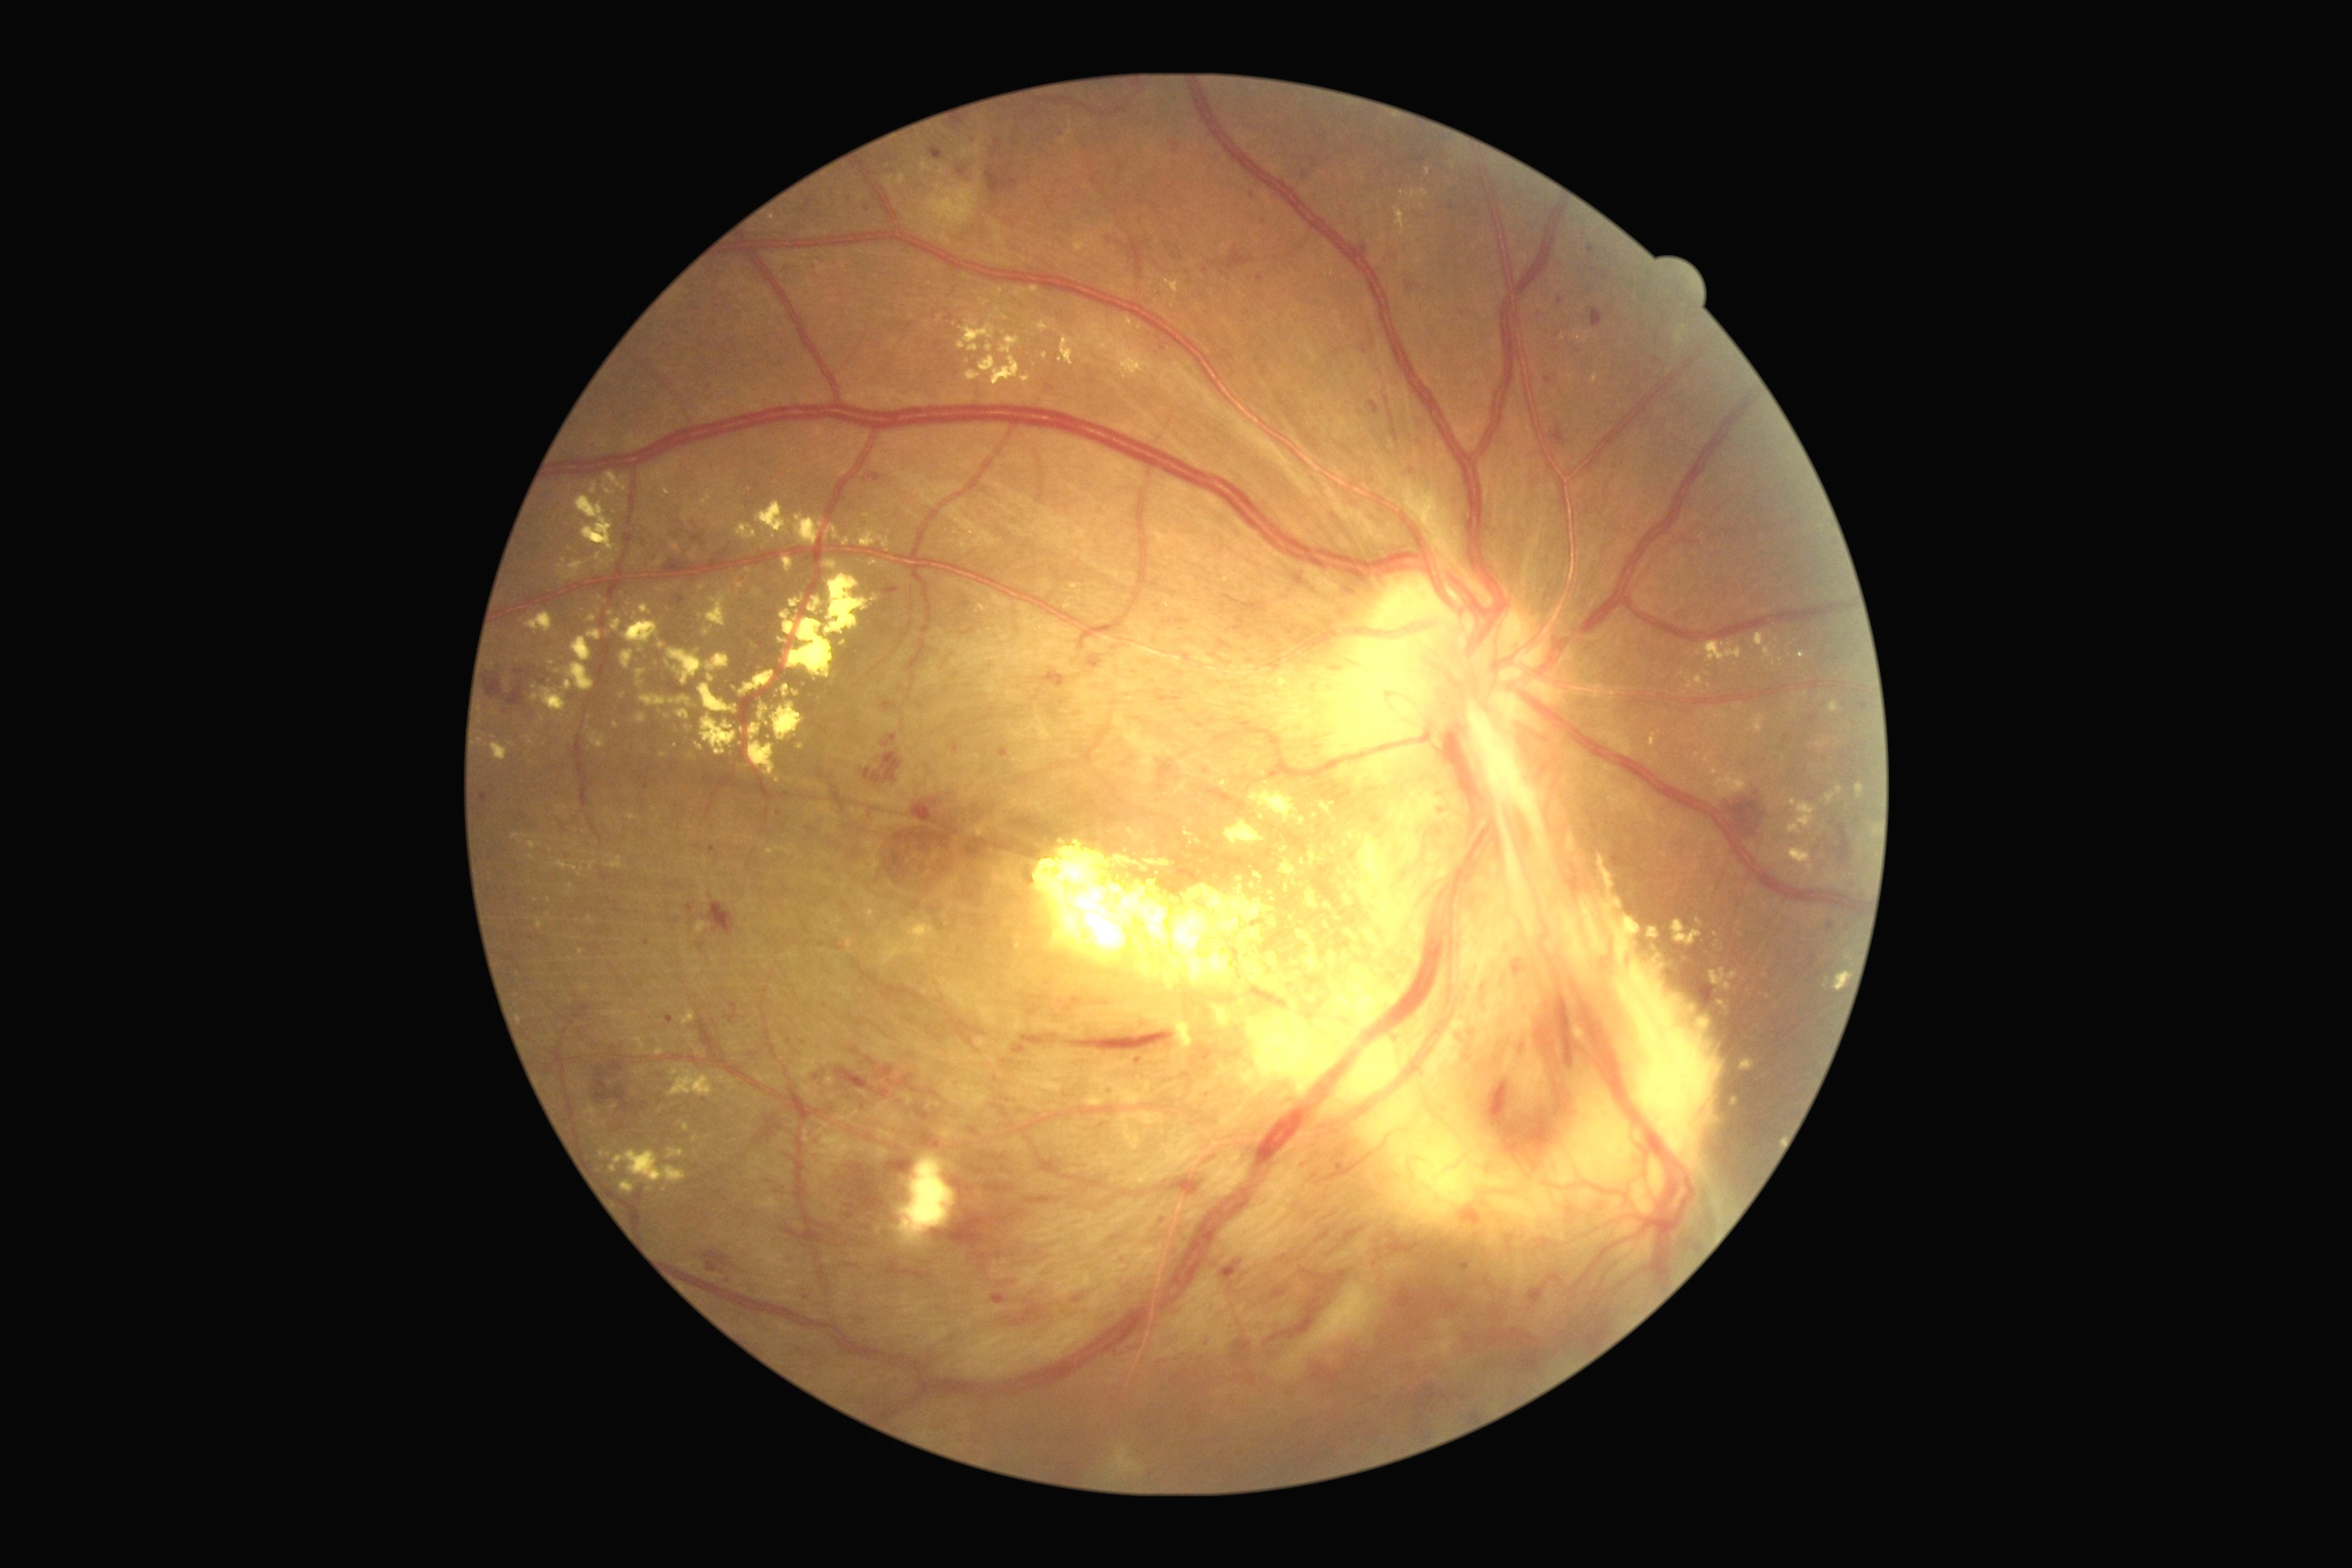 DR grade is 4 (PDR); proliferative diabetic retinopathy
Lesions identified (partial list):
EXs (subset) = 696,923,709,934 | 554,669,562,674 | 736,583,745,591 | 654,1048,665,1057 | 1827,787,1843,805 | 752,589,761,598 | 1669,917,1705,946 | 669,1064,714,1097 | 525,612,553,632 | 747,642,760,654 | 1034,841,1275,974 | 736,525,758,542 | 683,1010,696,1026
Smaller EXs around [x=998, y=311] | [x=676, y=747] | [x=1315, y=816] | [x=1774, y=663] | [x=846, y=541] | [x=782, y=641] | [x=580, y=953]
HEs (subset) = 1028,1197,1054,1204 | 1157,691,1184,703 | 856,1095,867,1112 | 1589,309,1603,328 | 839,1157,908,1244 | 676,596,685,609 | 912,801,939,825 | 1721,790,1767,839 | 1542,426,1569,446 | 1298,1268,1344,1304 | 992,1295,1006,1304 | 1469,1407,1476,1416 | 1367,402,1380,415 | 1159,765,1173,779 | 986,168,1019,195 | 870,752,903,785 | 919,1130,941,1150 | 1418,155,1427,164
Smaller HEs around [x=1260, y=278] | [x=1413, y=158]
MAs (subset) = 1602,271,1609,280 | 957,168,966,177 | 1170,142,1181,153 | 1576,348,1582,358 | 778,810,783,818 | 1587,244,1596,255 | 1104,1090,1113,1095 | 687,905,694,914 | 1460,1264,1471,1273
Smaller MAs around [x=825, y=1007] | [x=1138, y=1060] | [x=1864, y=707] | [x=701, y=946] | [x=956, y=748] | [x=1452, y=207] | [x=1594, y=270]